2212 x 1659 pixels
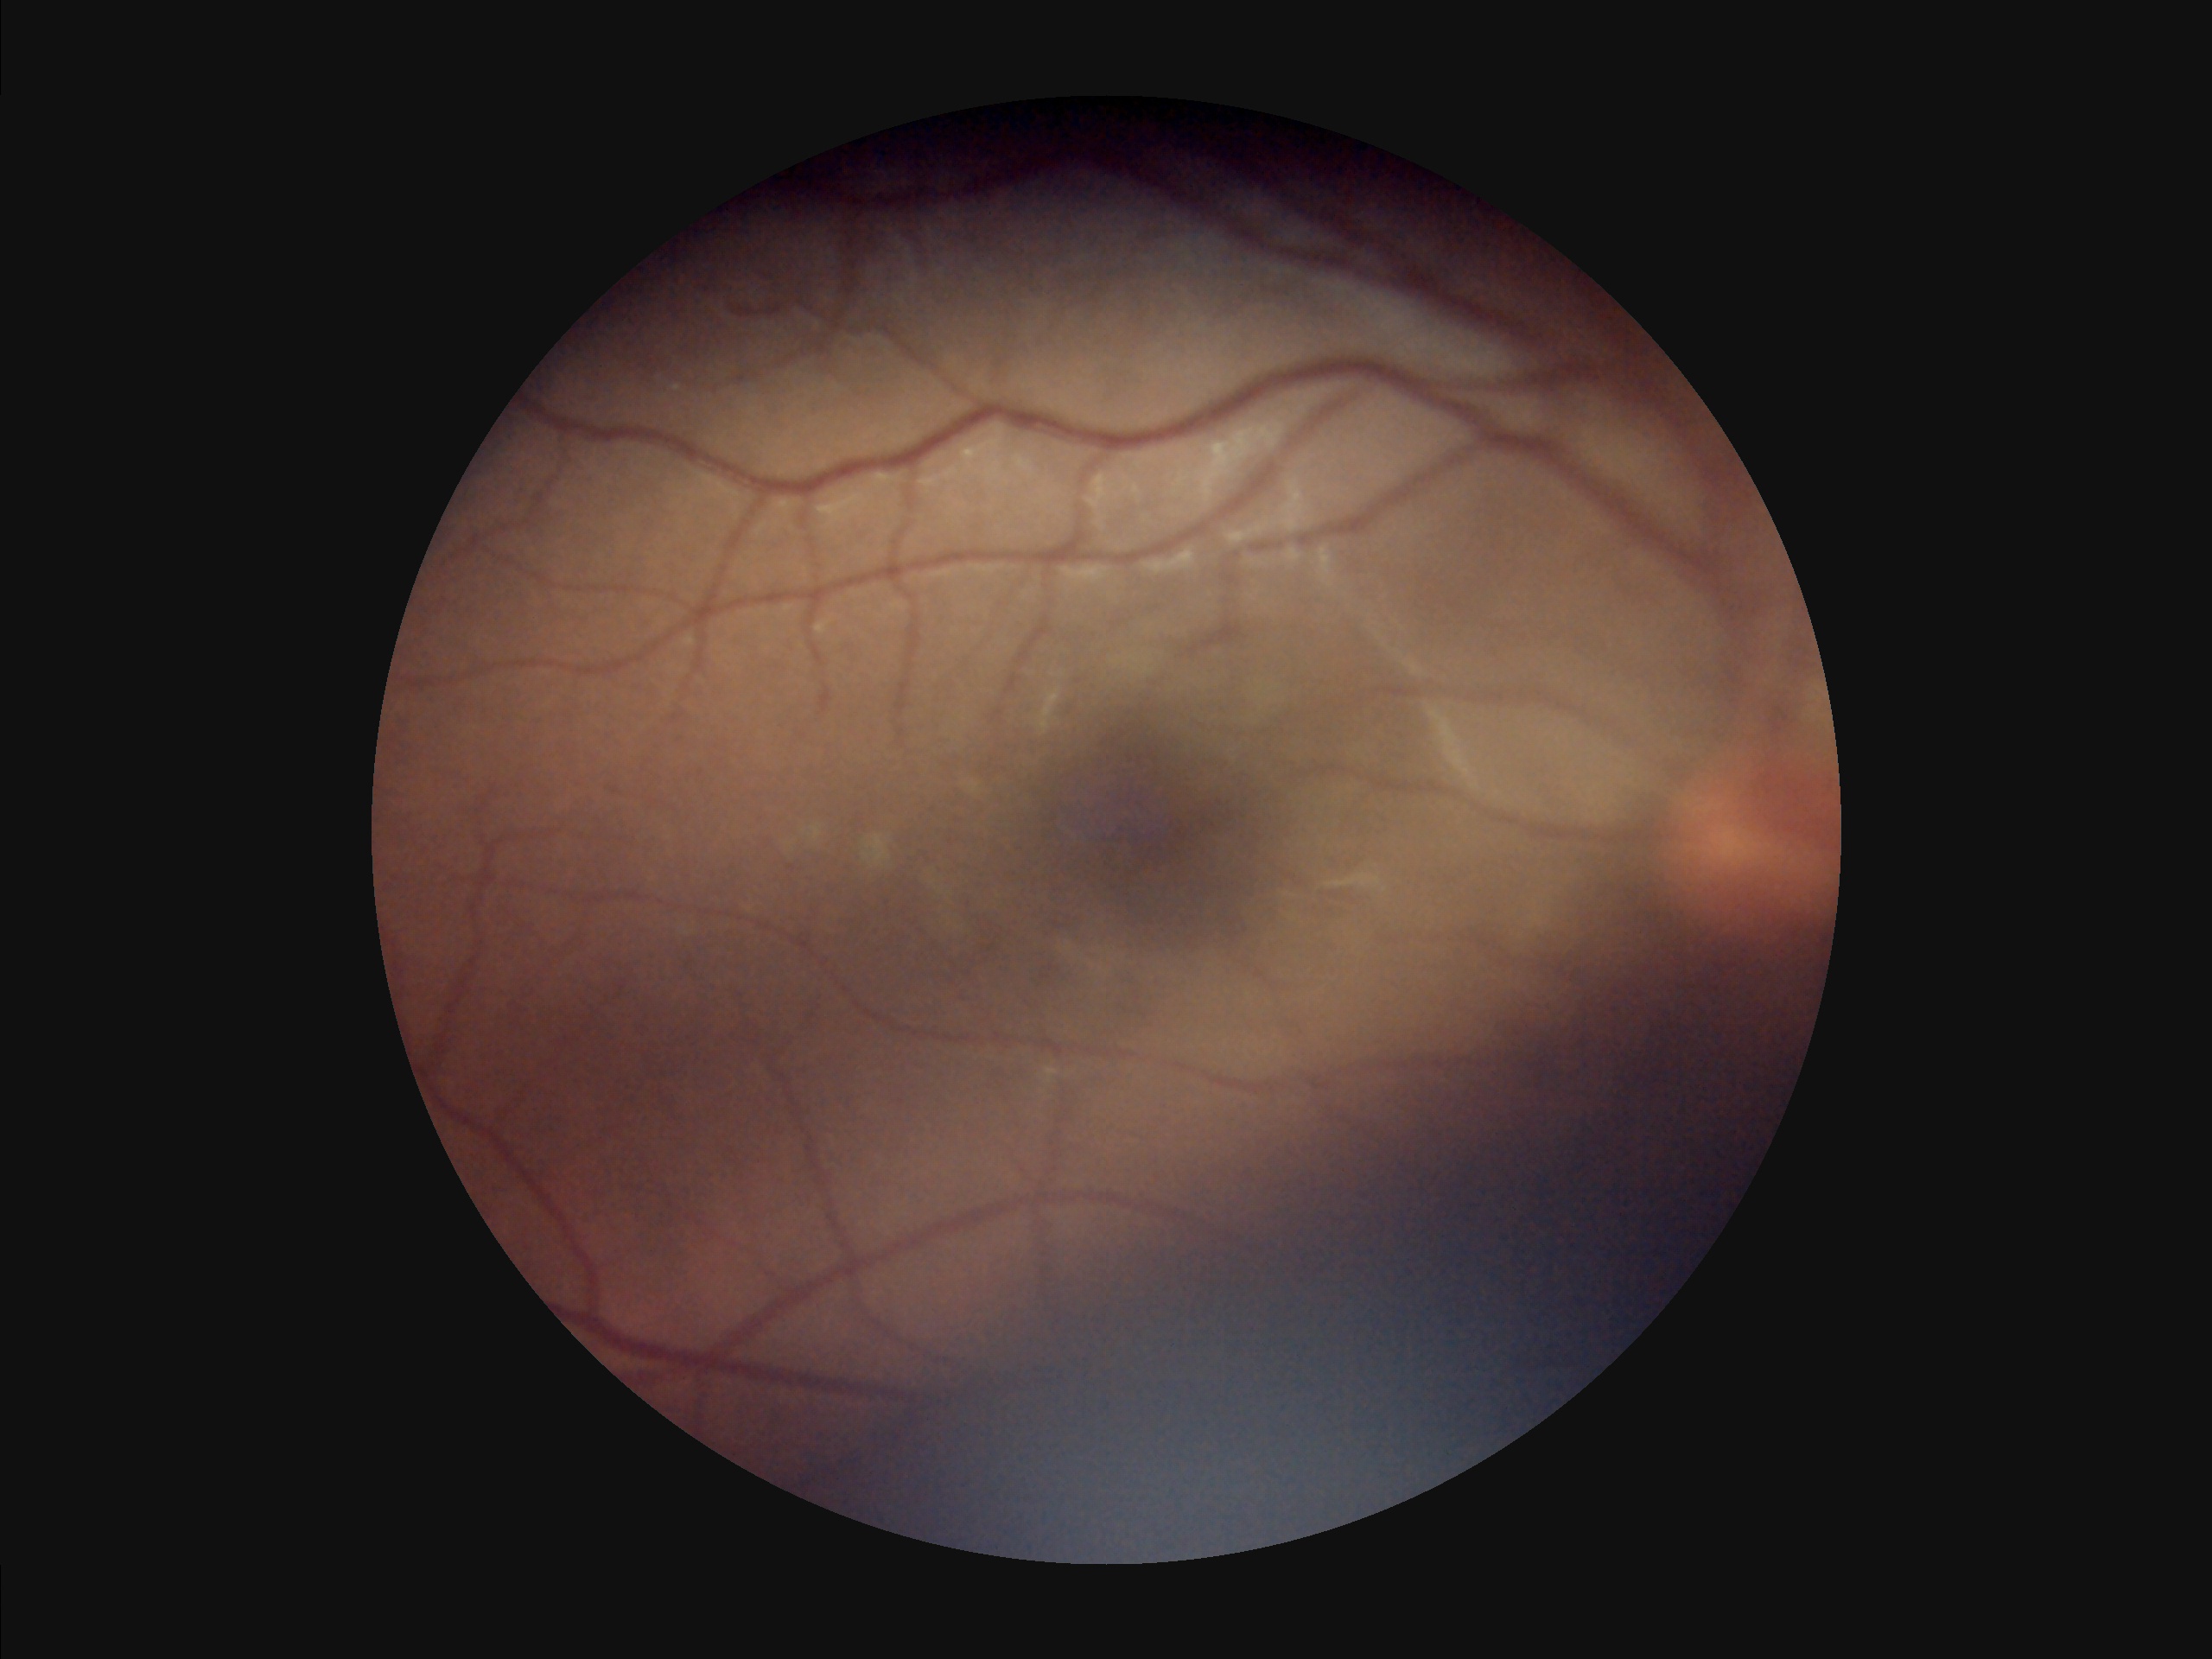
Image quality:
- overall: low
- focus: sharp
- illumination: uneven